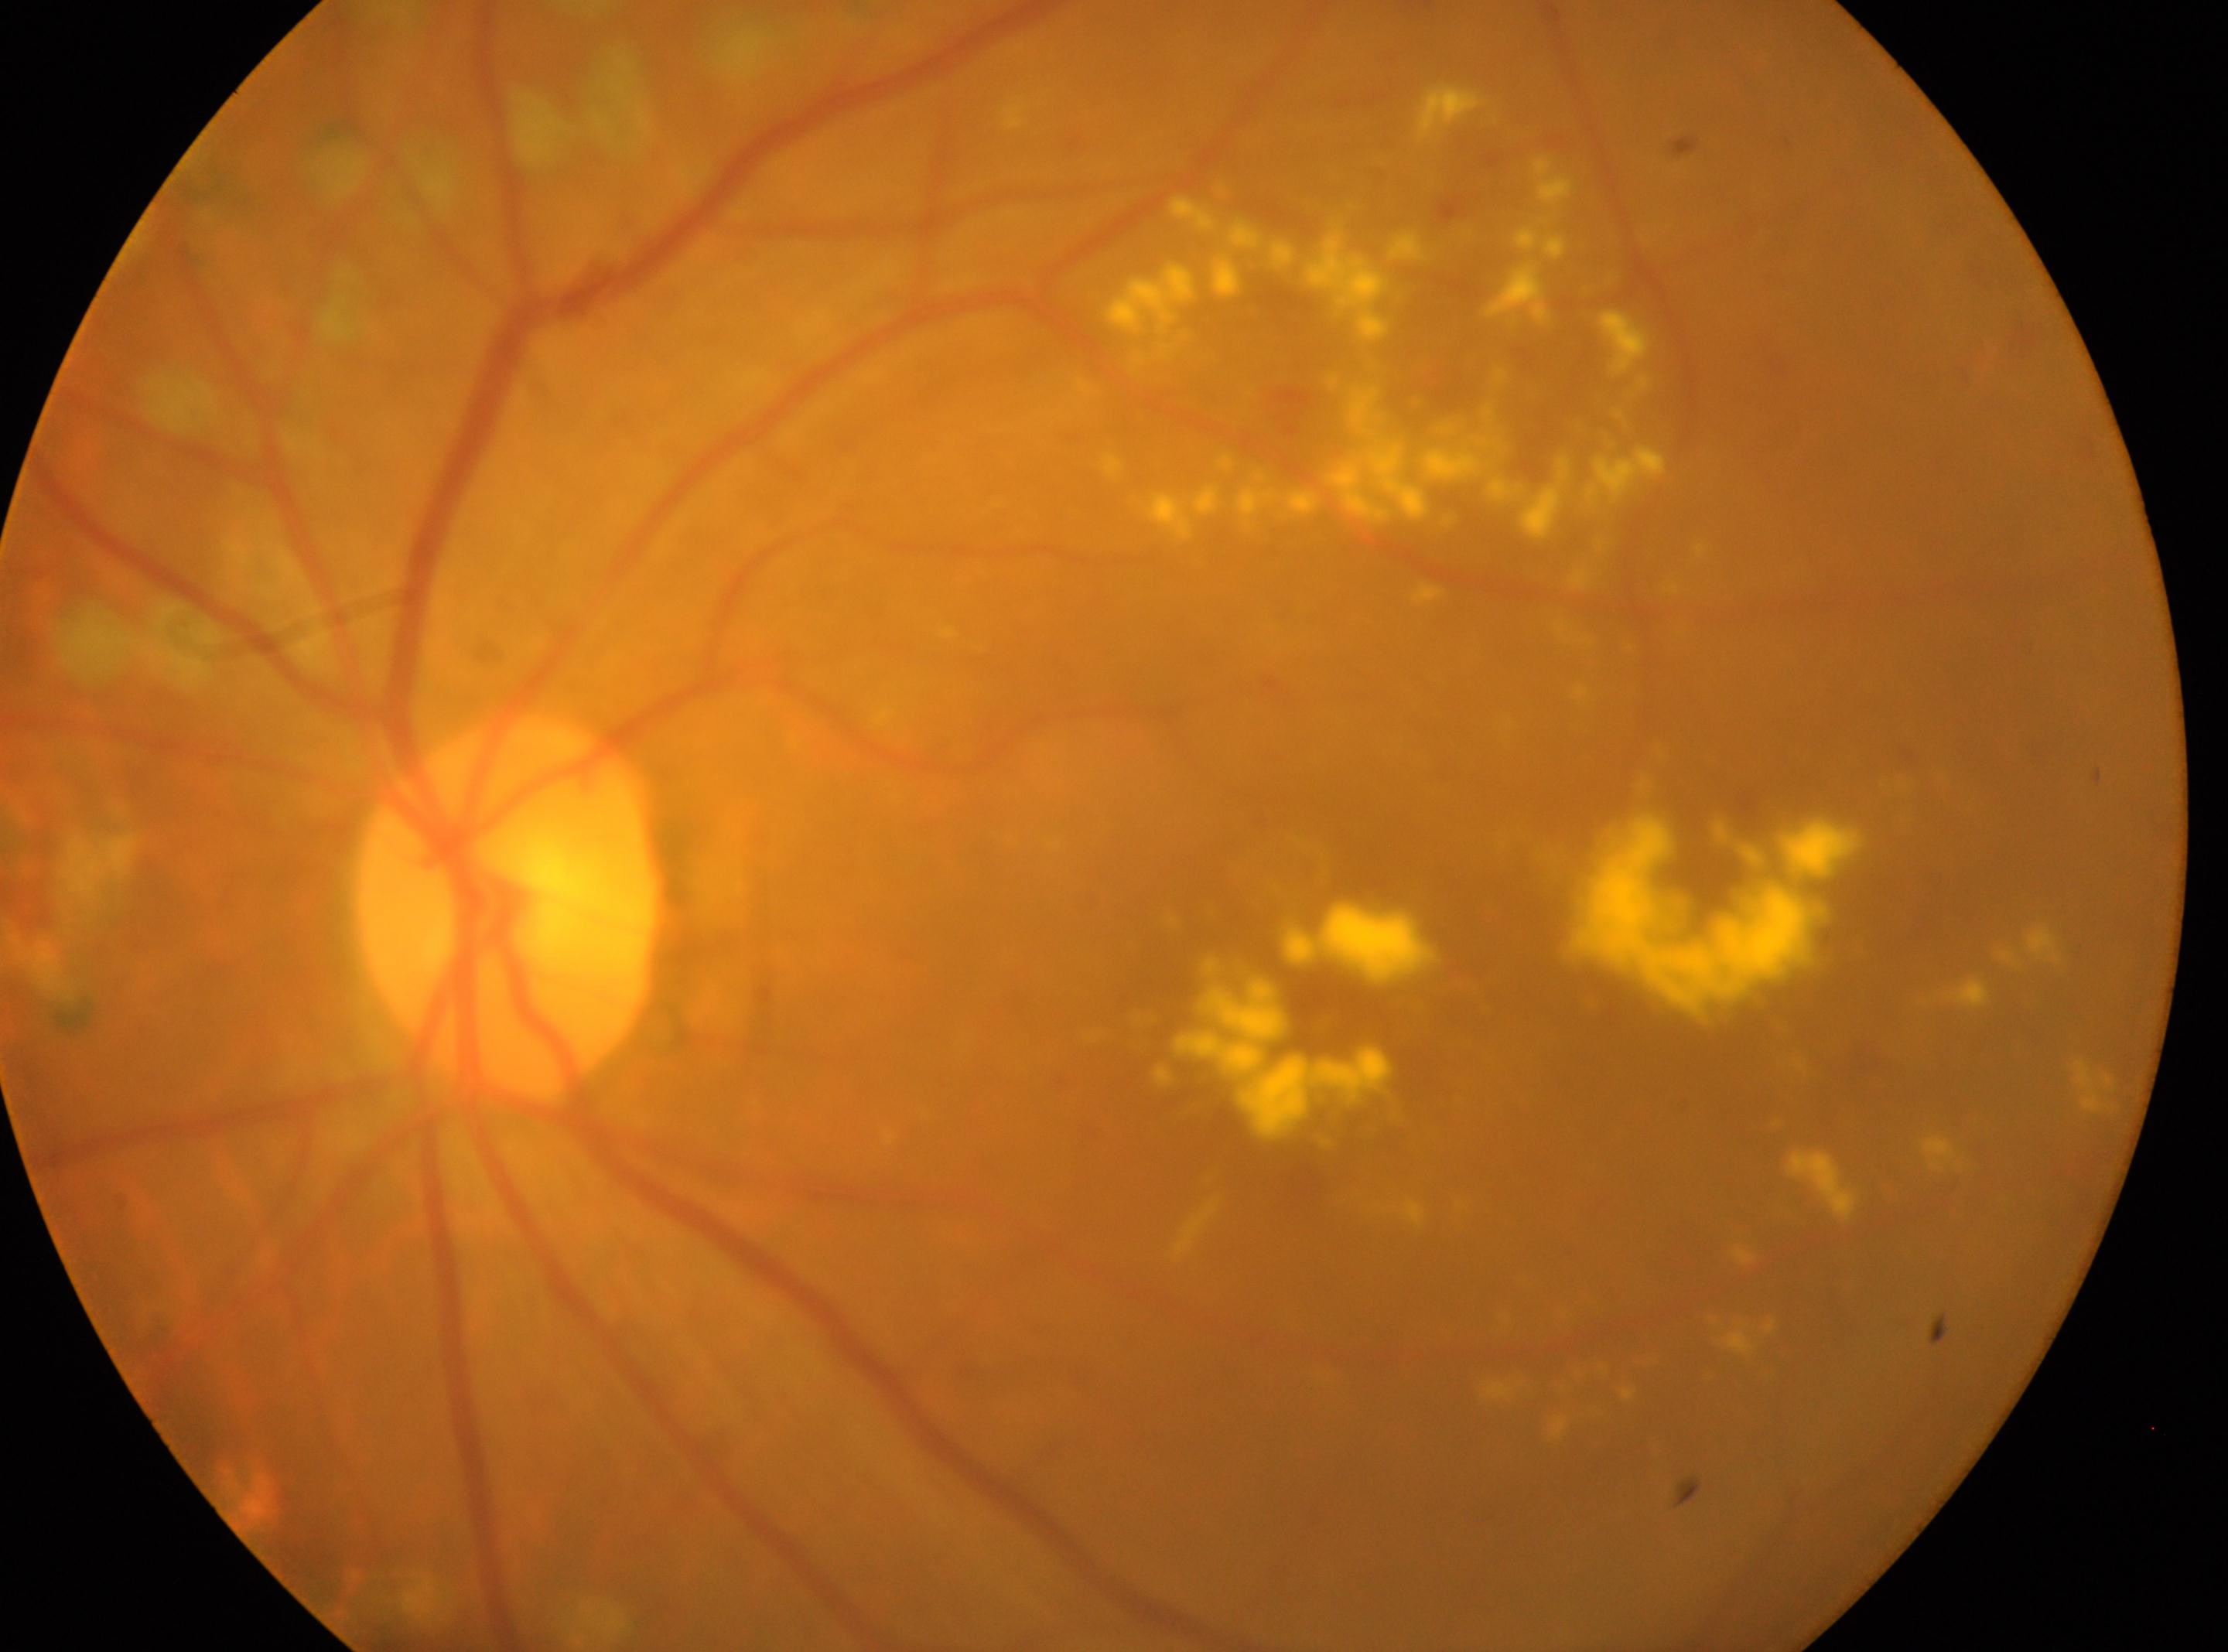
Findings:
* macular center · (1314,1012)
* retinopathy · post-laser DR, with underlying moderate non-proliferative diabetic retinopathy (grade 2)
* eye · OS
* disc center · (505,906)